No pharmacologic dilation. Camera: NIDEK AFC-230
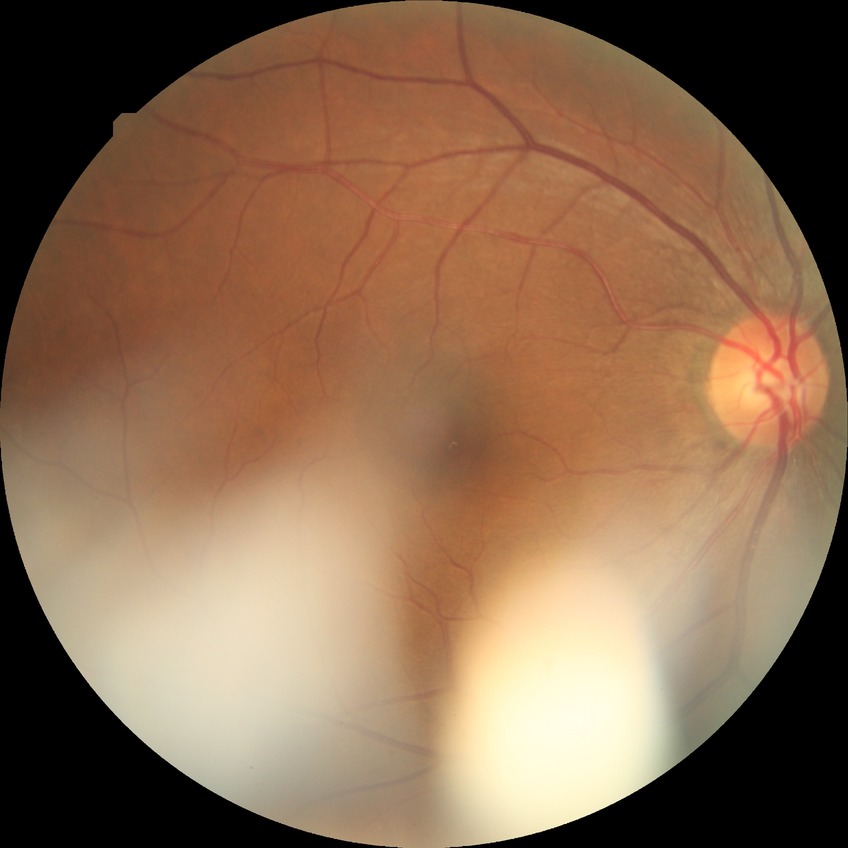
Findings:
• Davis DR grade — NDR